Modified Davis classification: 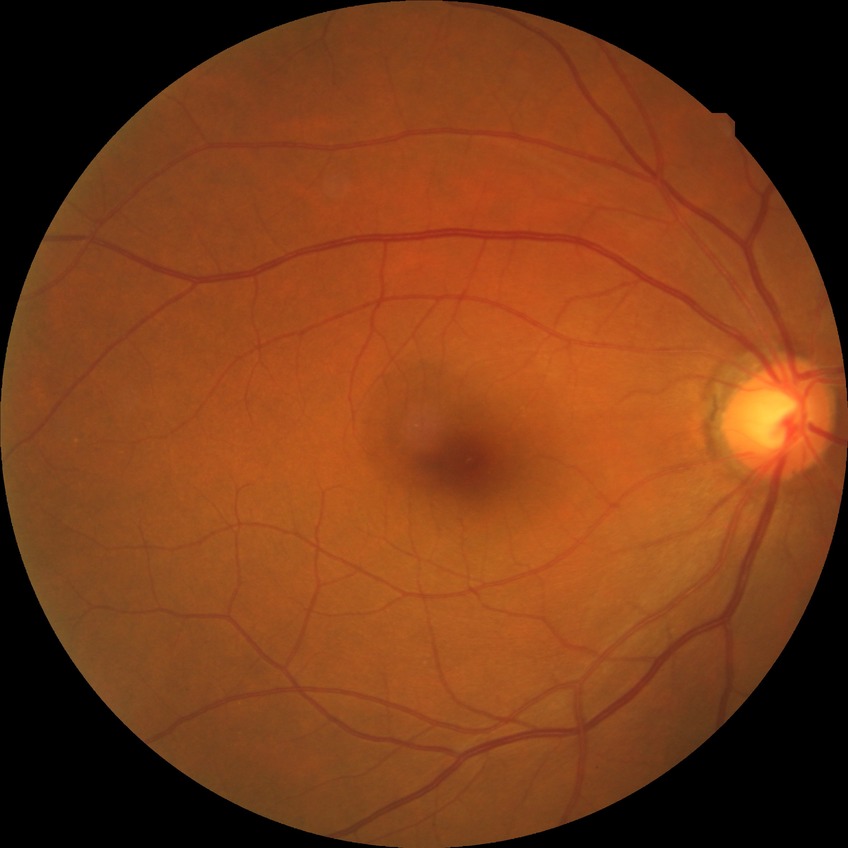
diabetic retinopathy severity=no diabetic retinopathy.